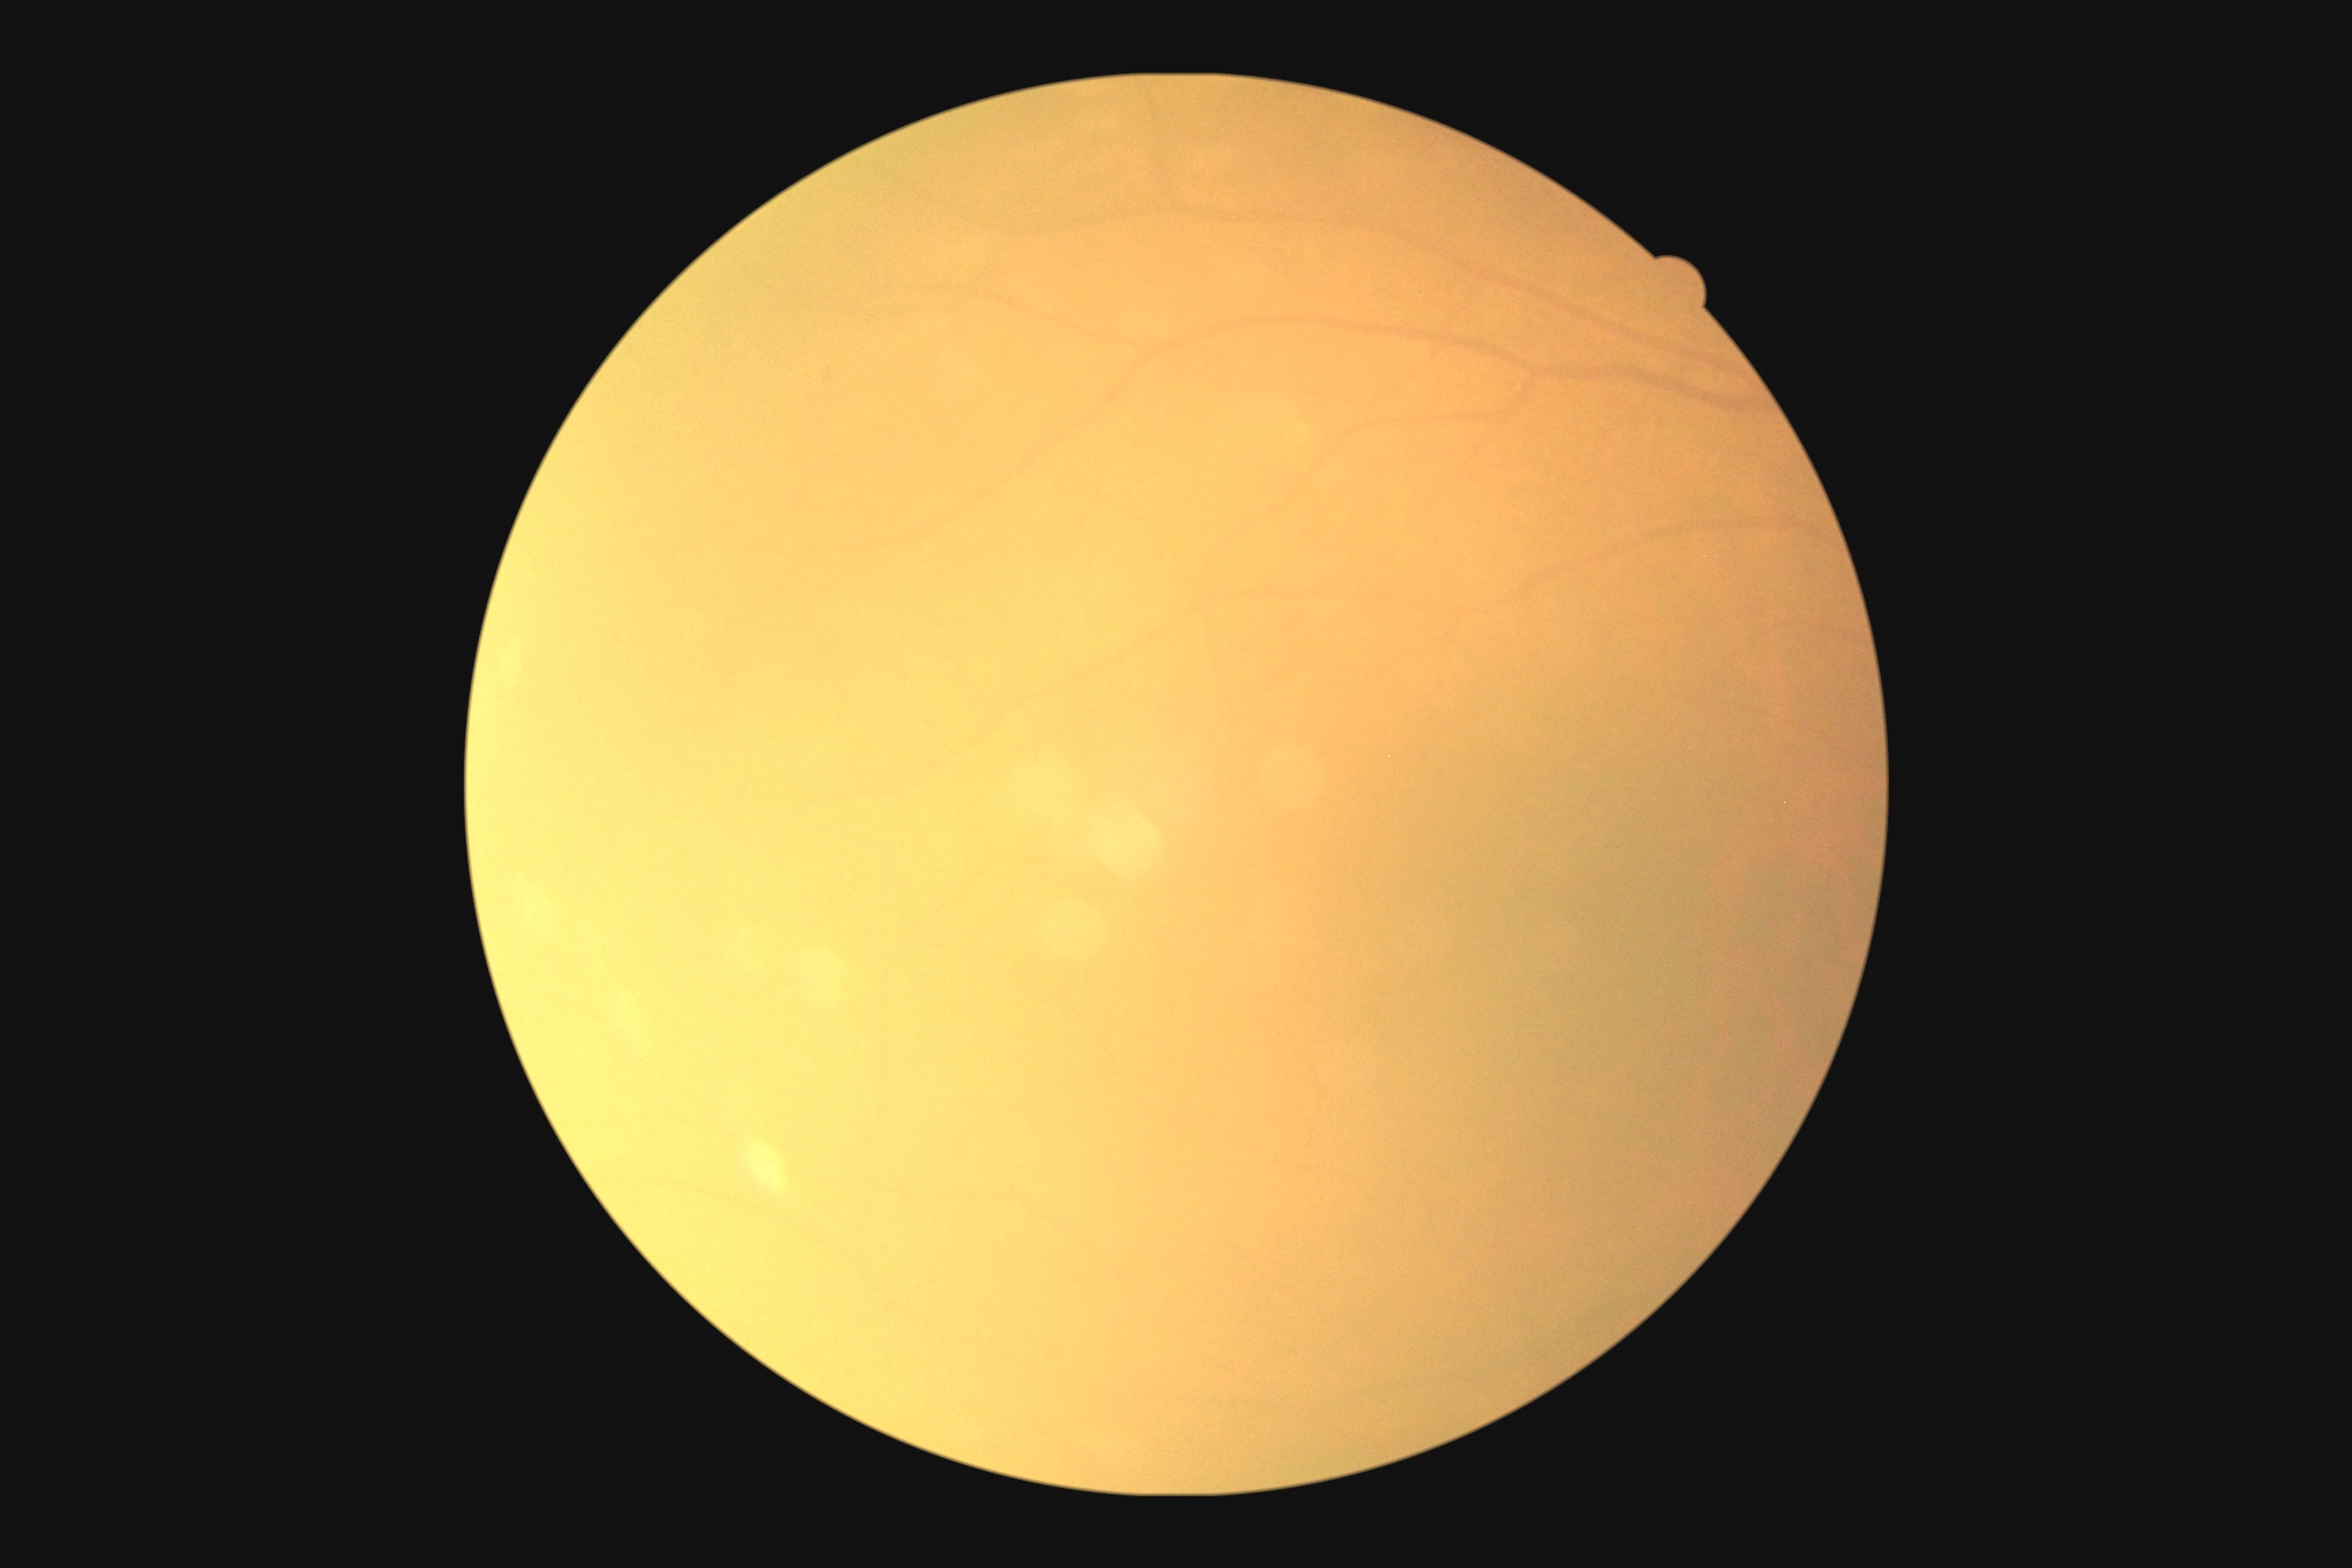 DR: ungradable due to poor image quality.